No pharmacologic dilation: 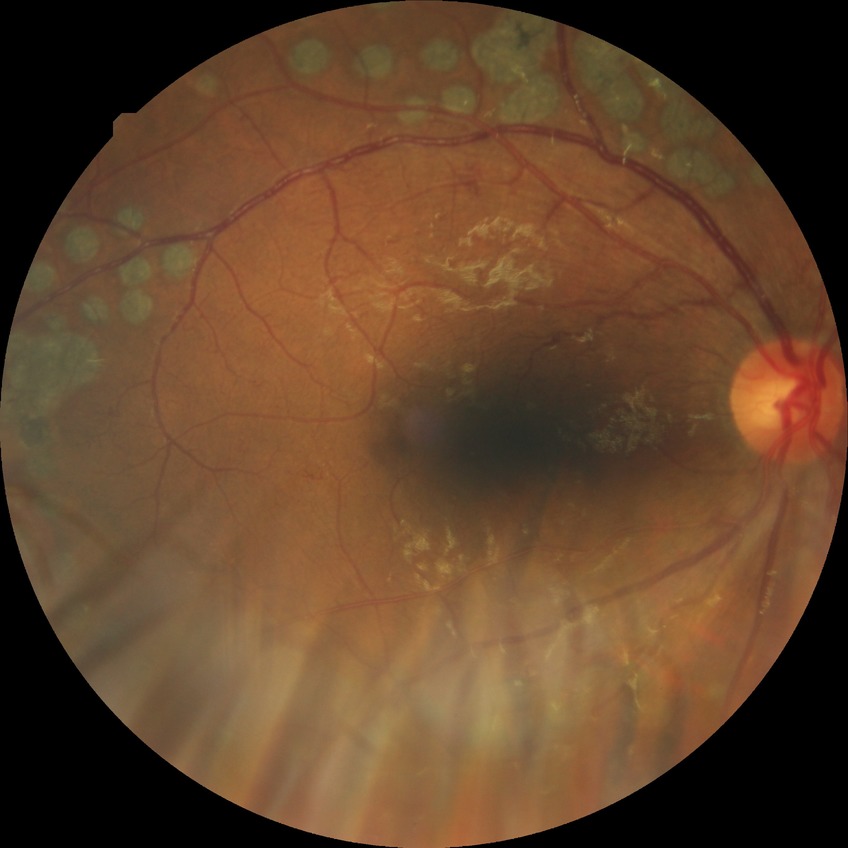
• Davis grade — PDR